2144 x 1424 pixels; FOV: 45 degrees — 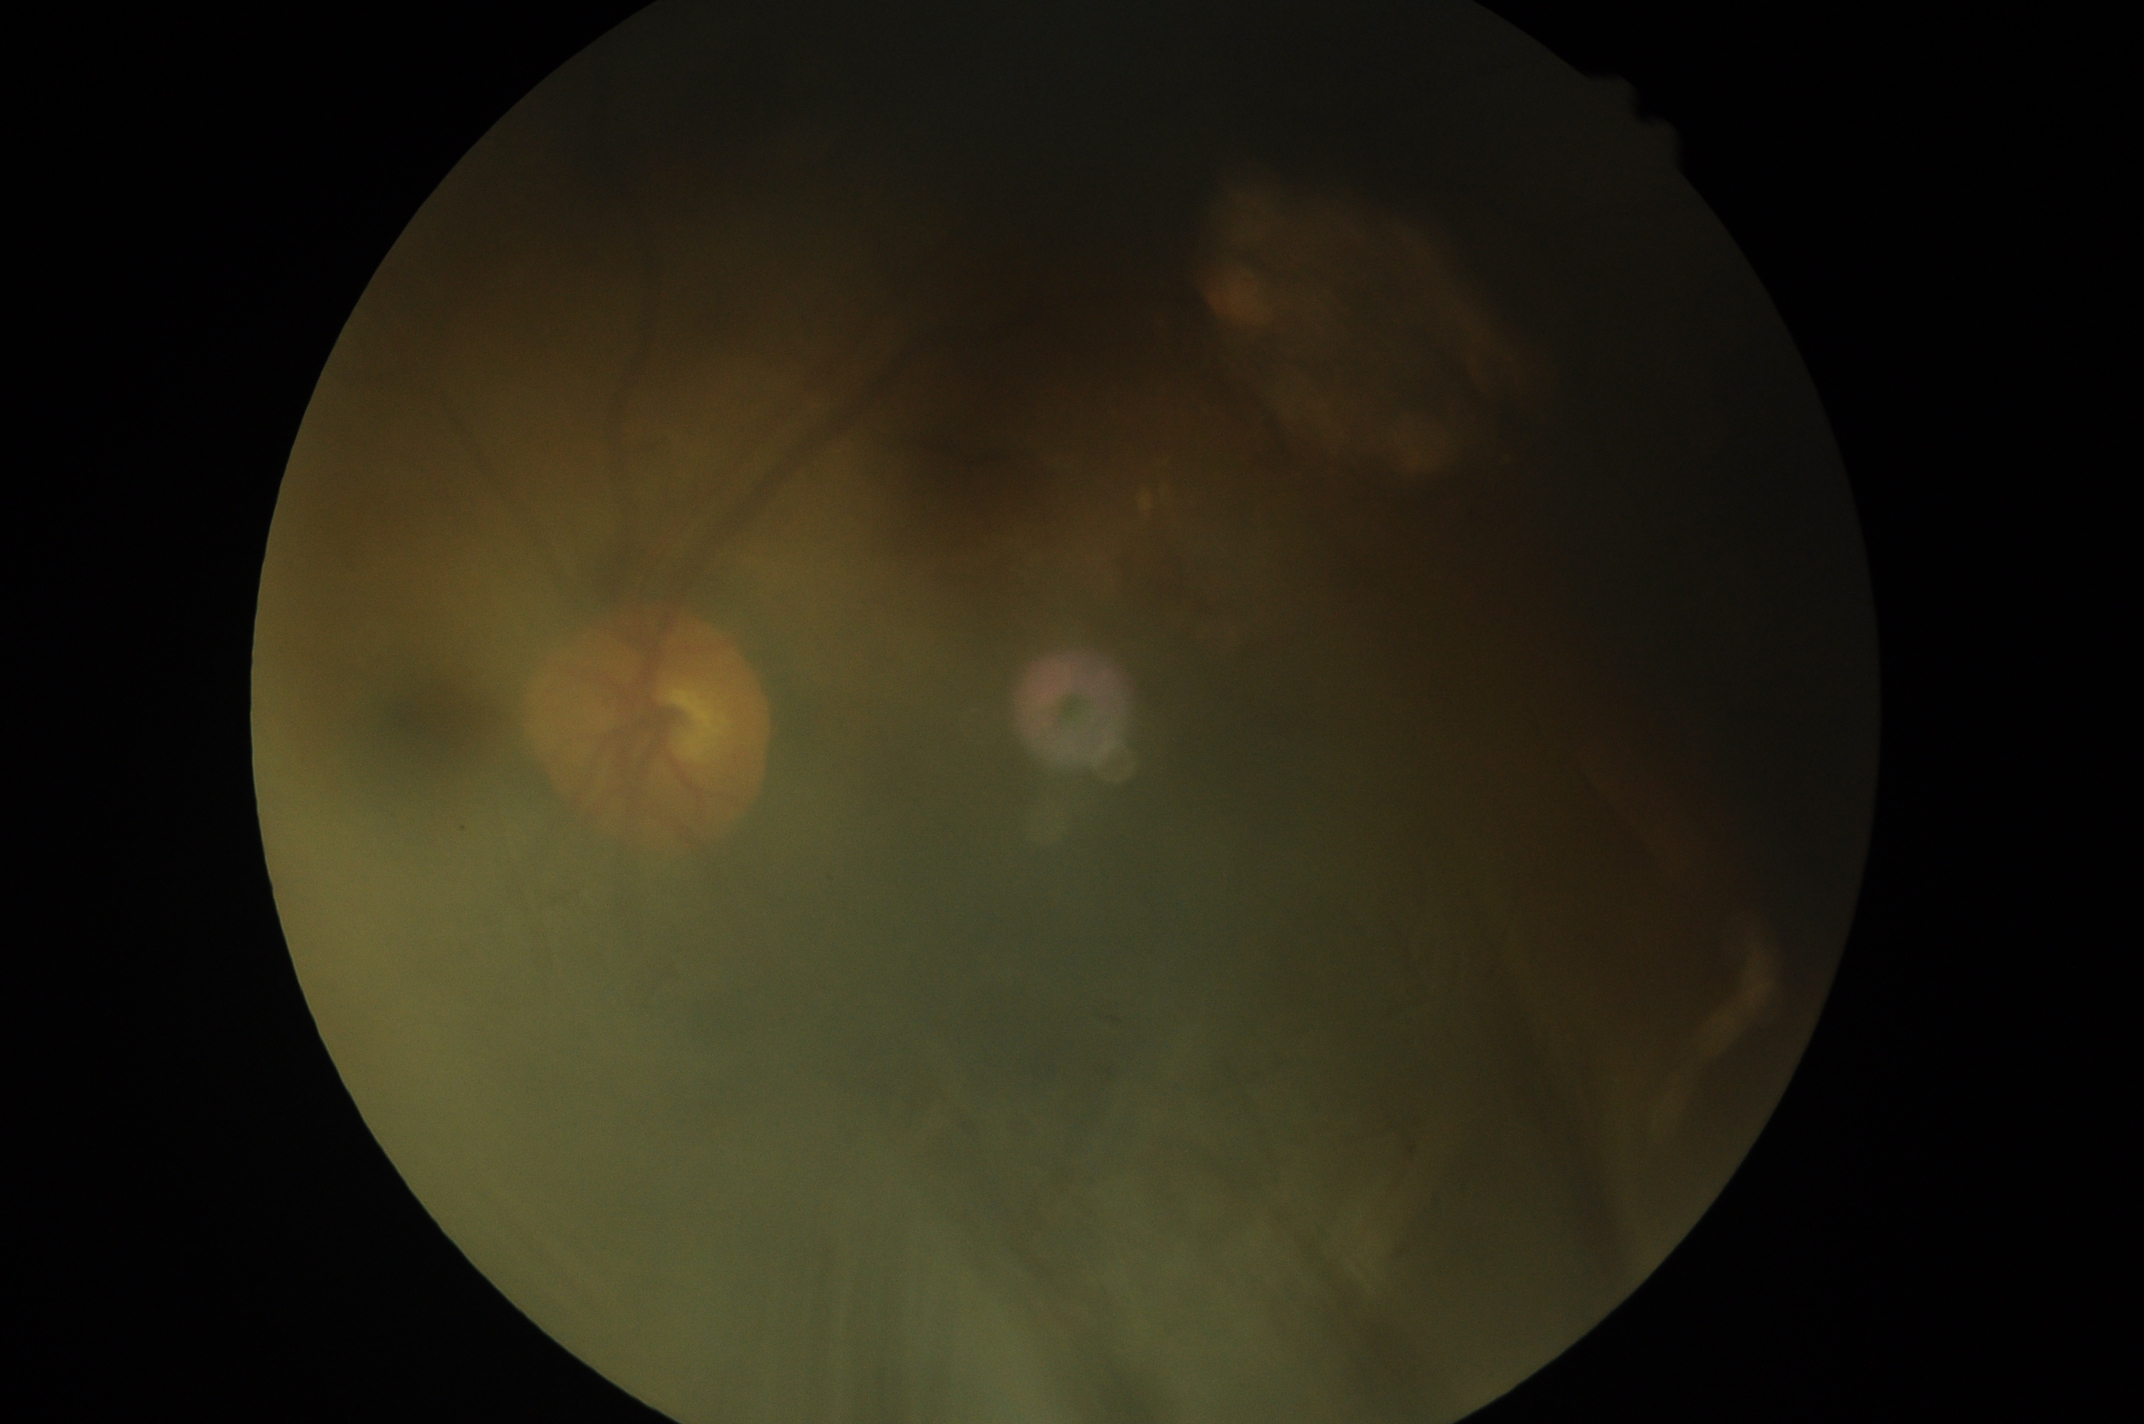
DR grade is ungradable. Image quality is insufficient for diabetic retinopathy assessment.